45-degree field of view: 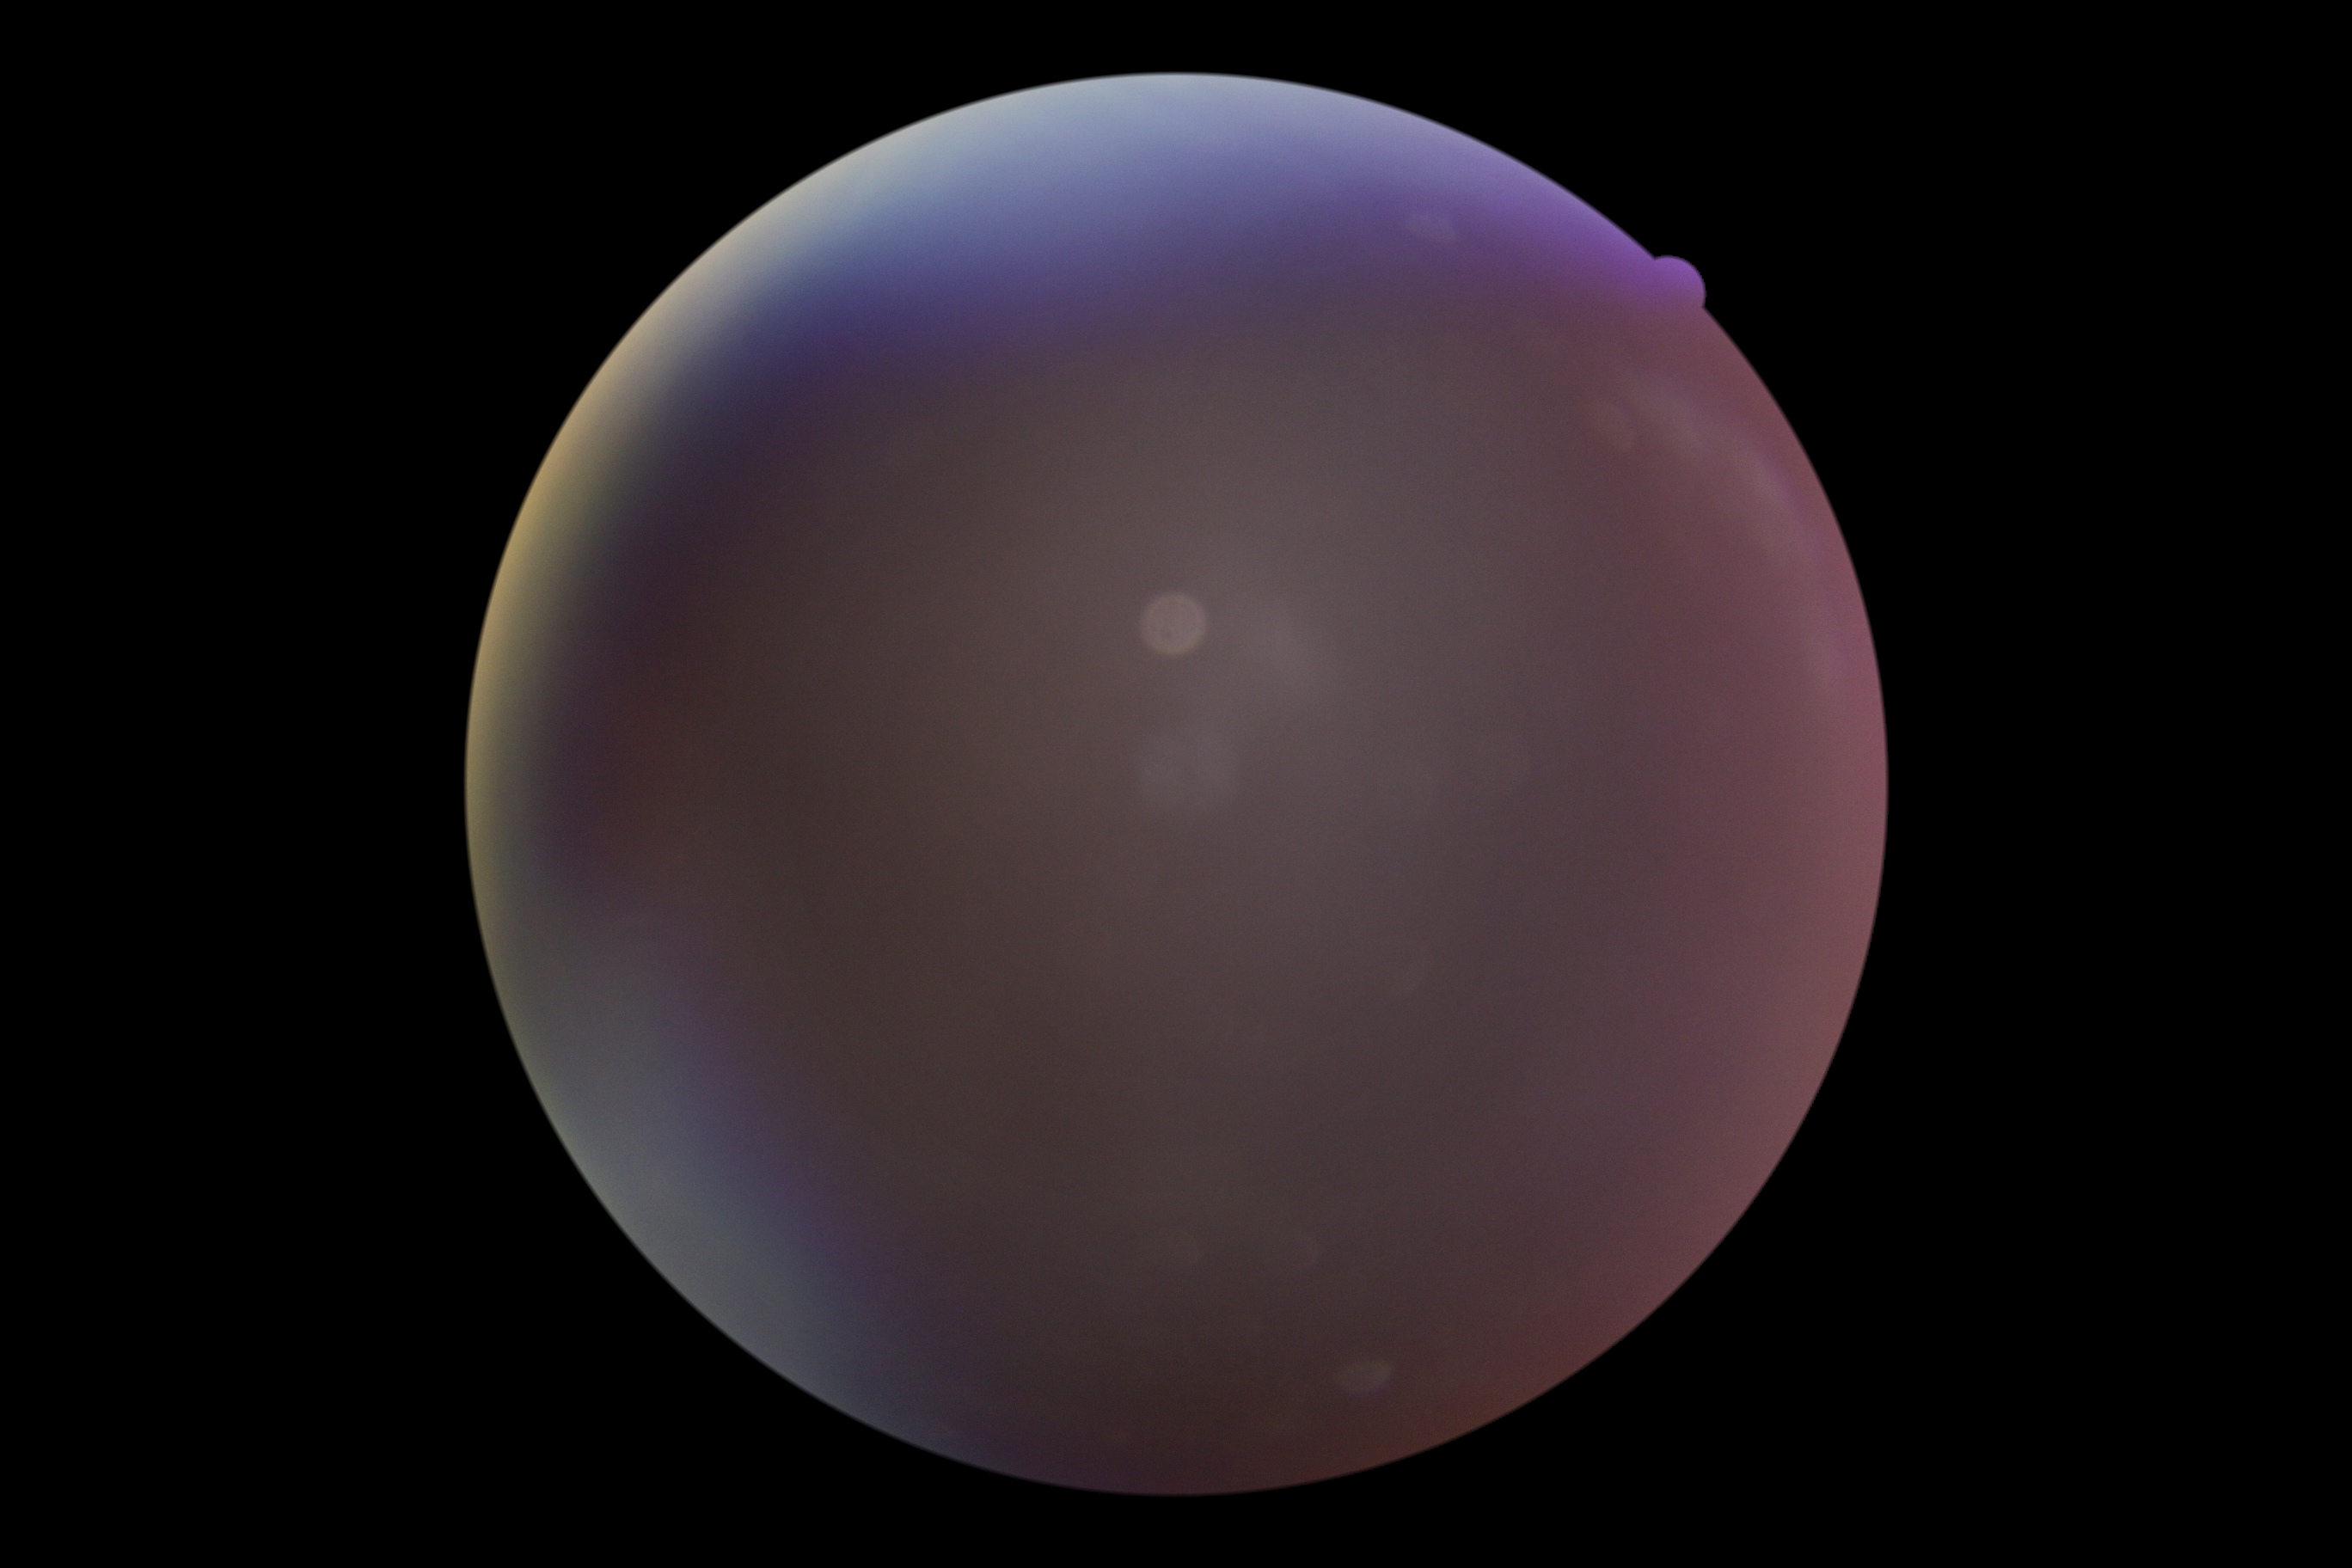 Findings:
- diabetic retinopathy grade: ungradable due to poor image quality
- image quality: insufficient for DR assessment